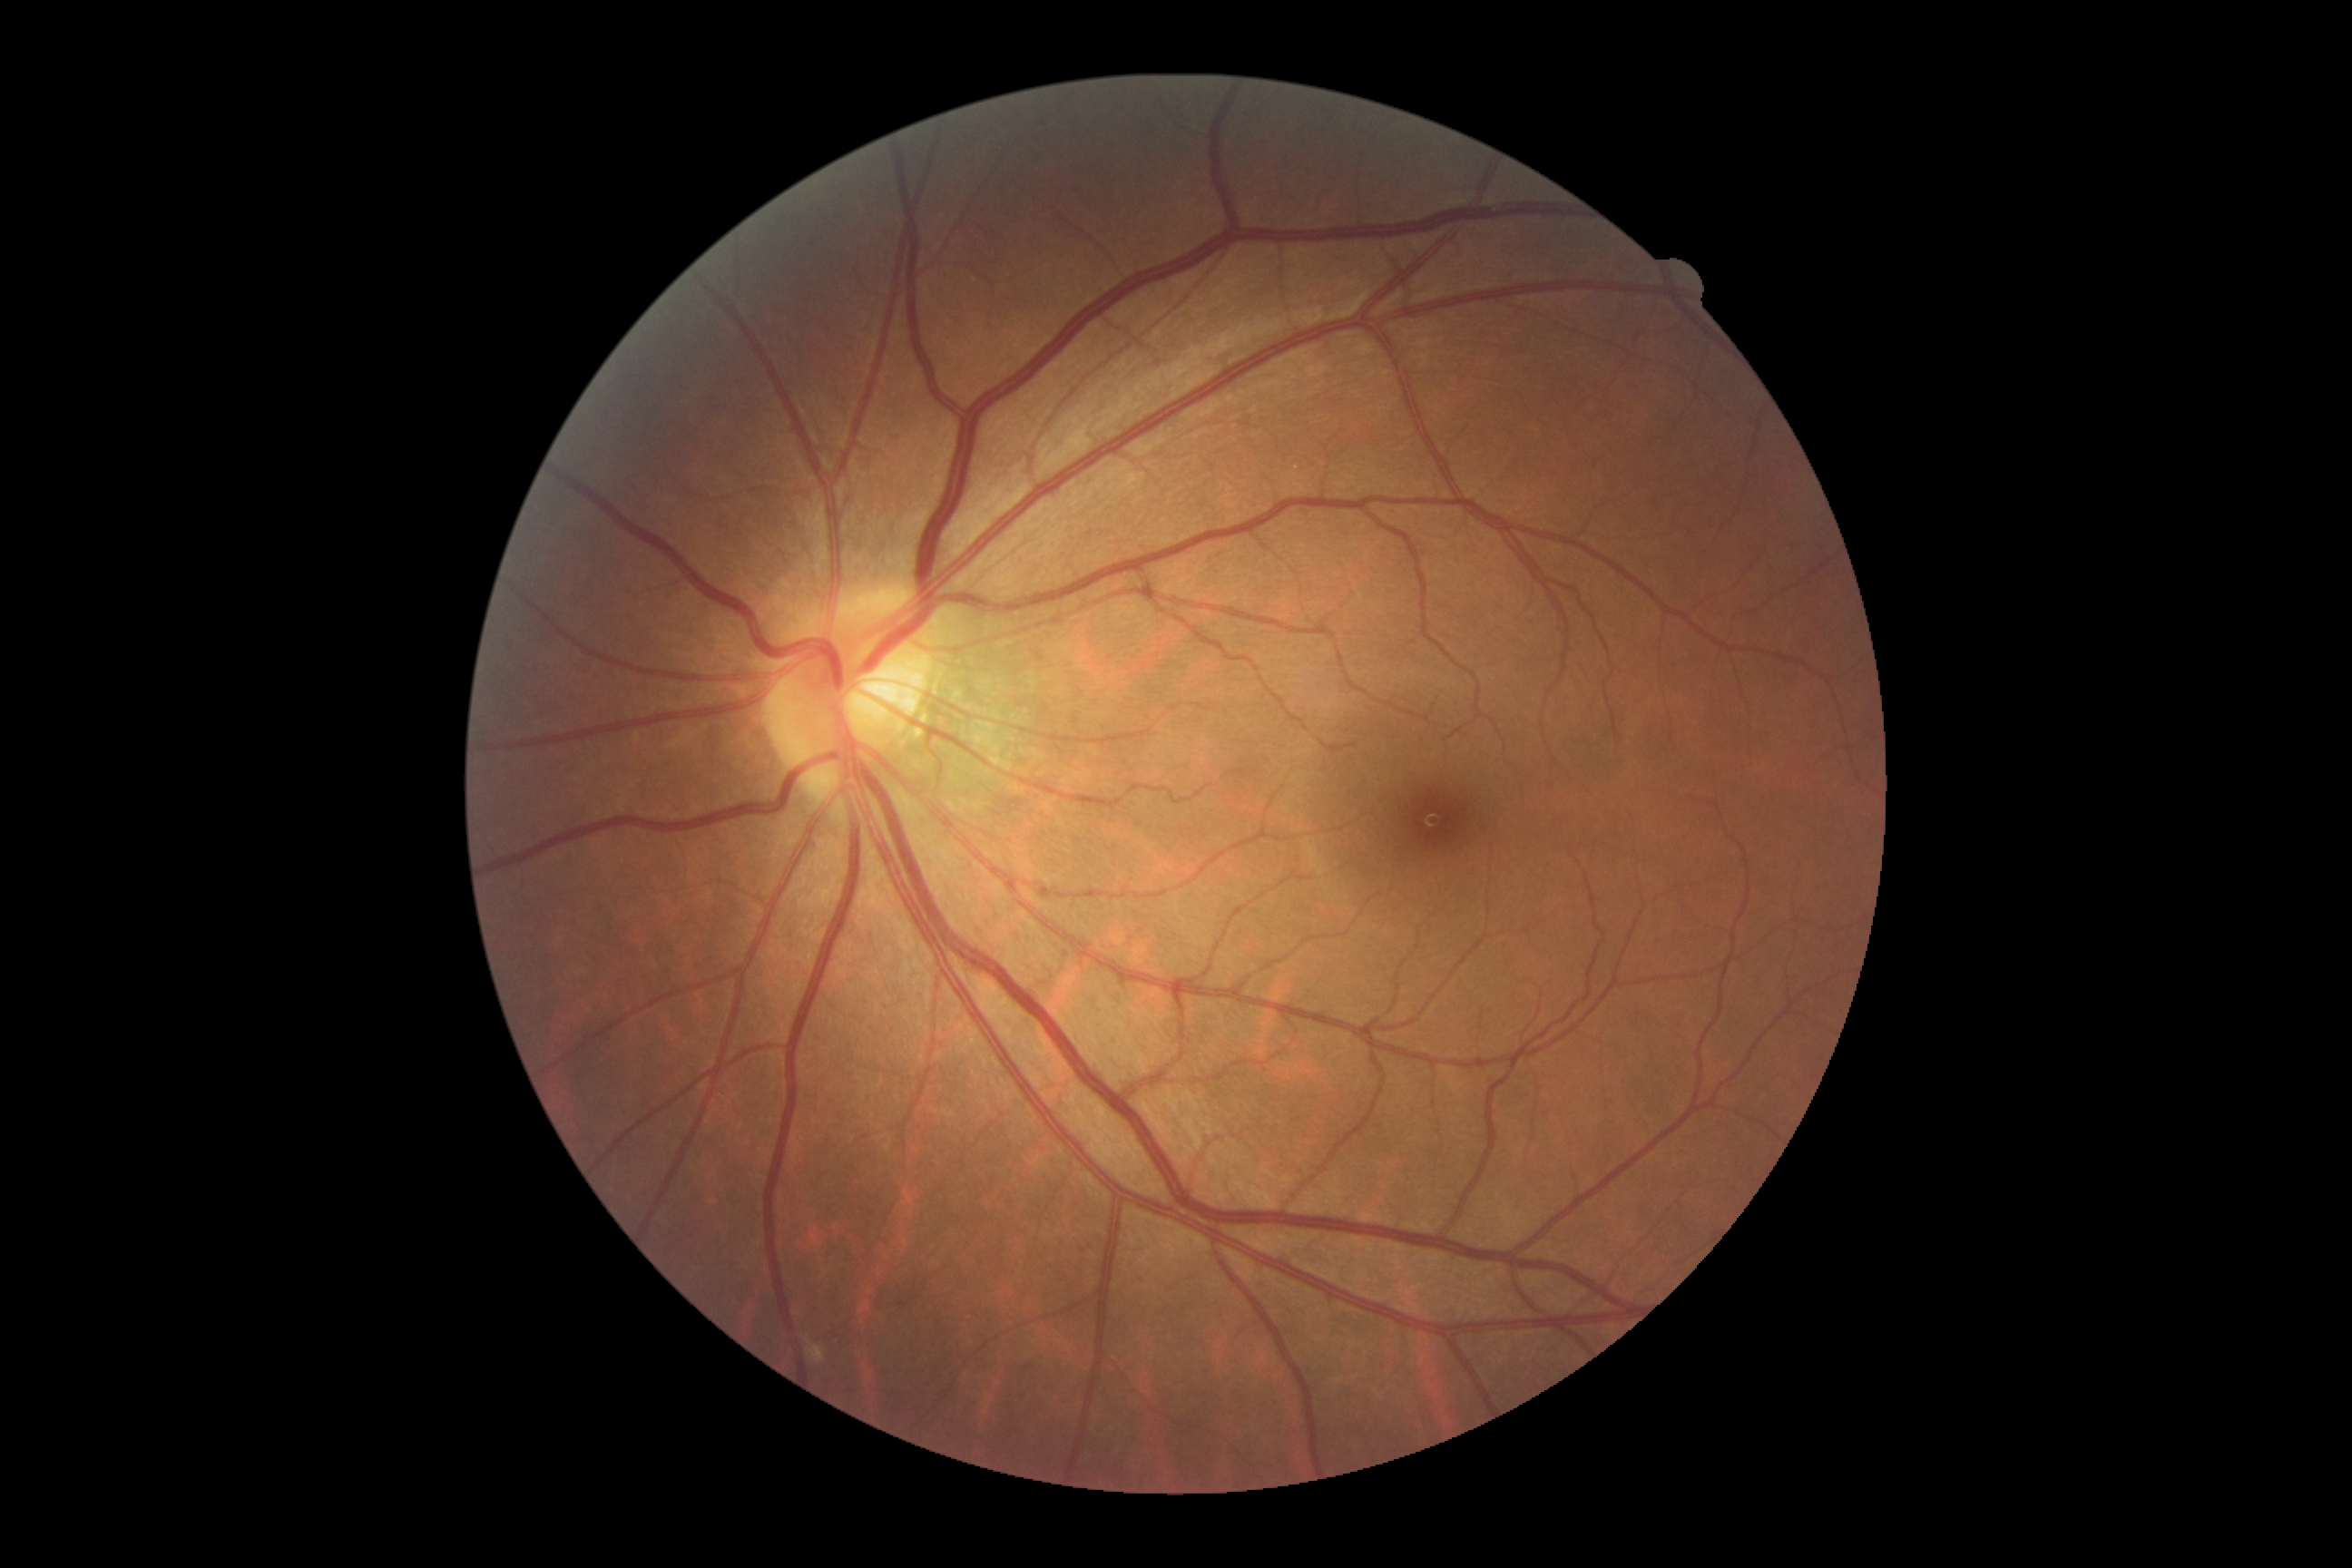

DR impression: no apparent DR; diabetic retinopathy severity: grade 0 (no apparent retinopathy) — no visible signs of diabetic retinopathy.